Retinal fundus photograph. Image size 2352x1568 — 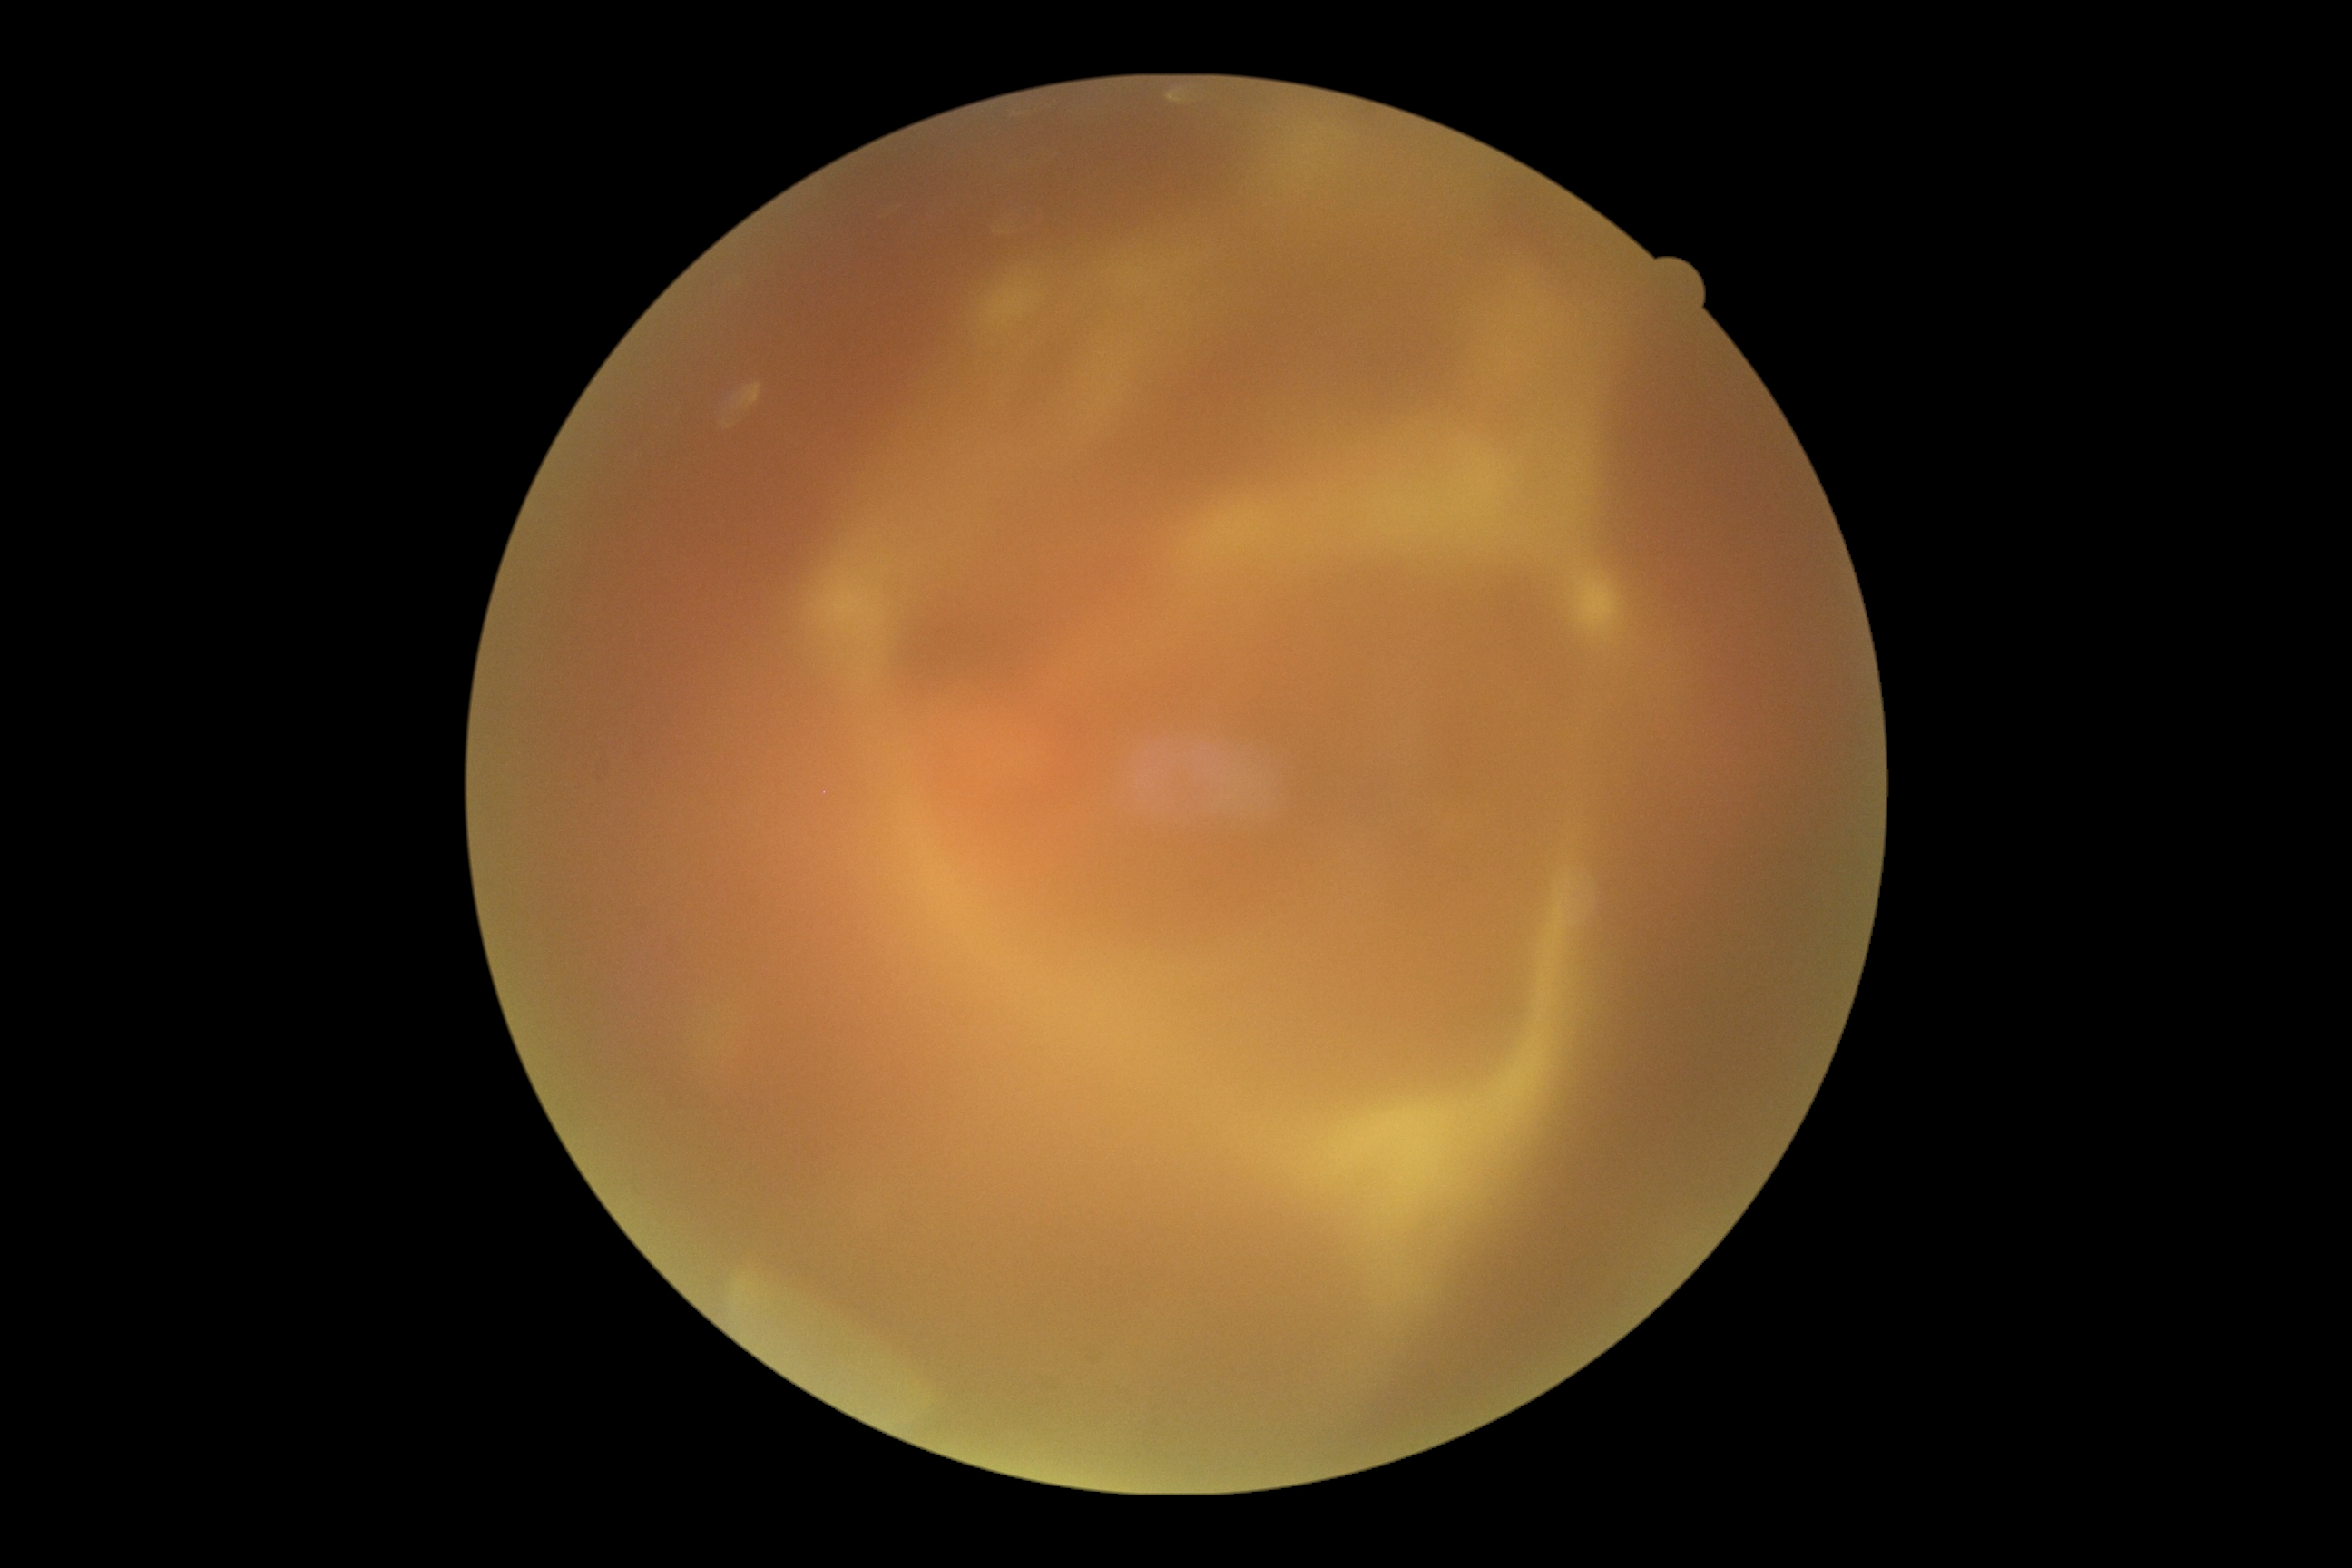 Findings:
* image quality — insufficient for DR assessment
* DR grade — ungradable